Wide-field retinal mosaic image — 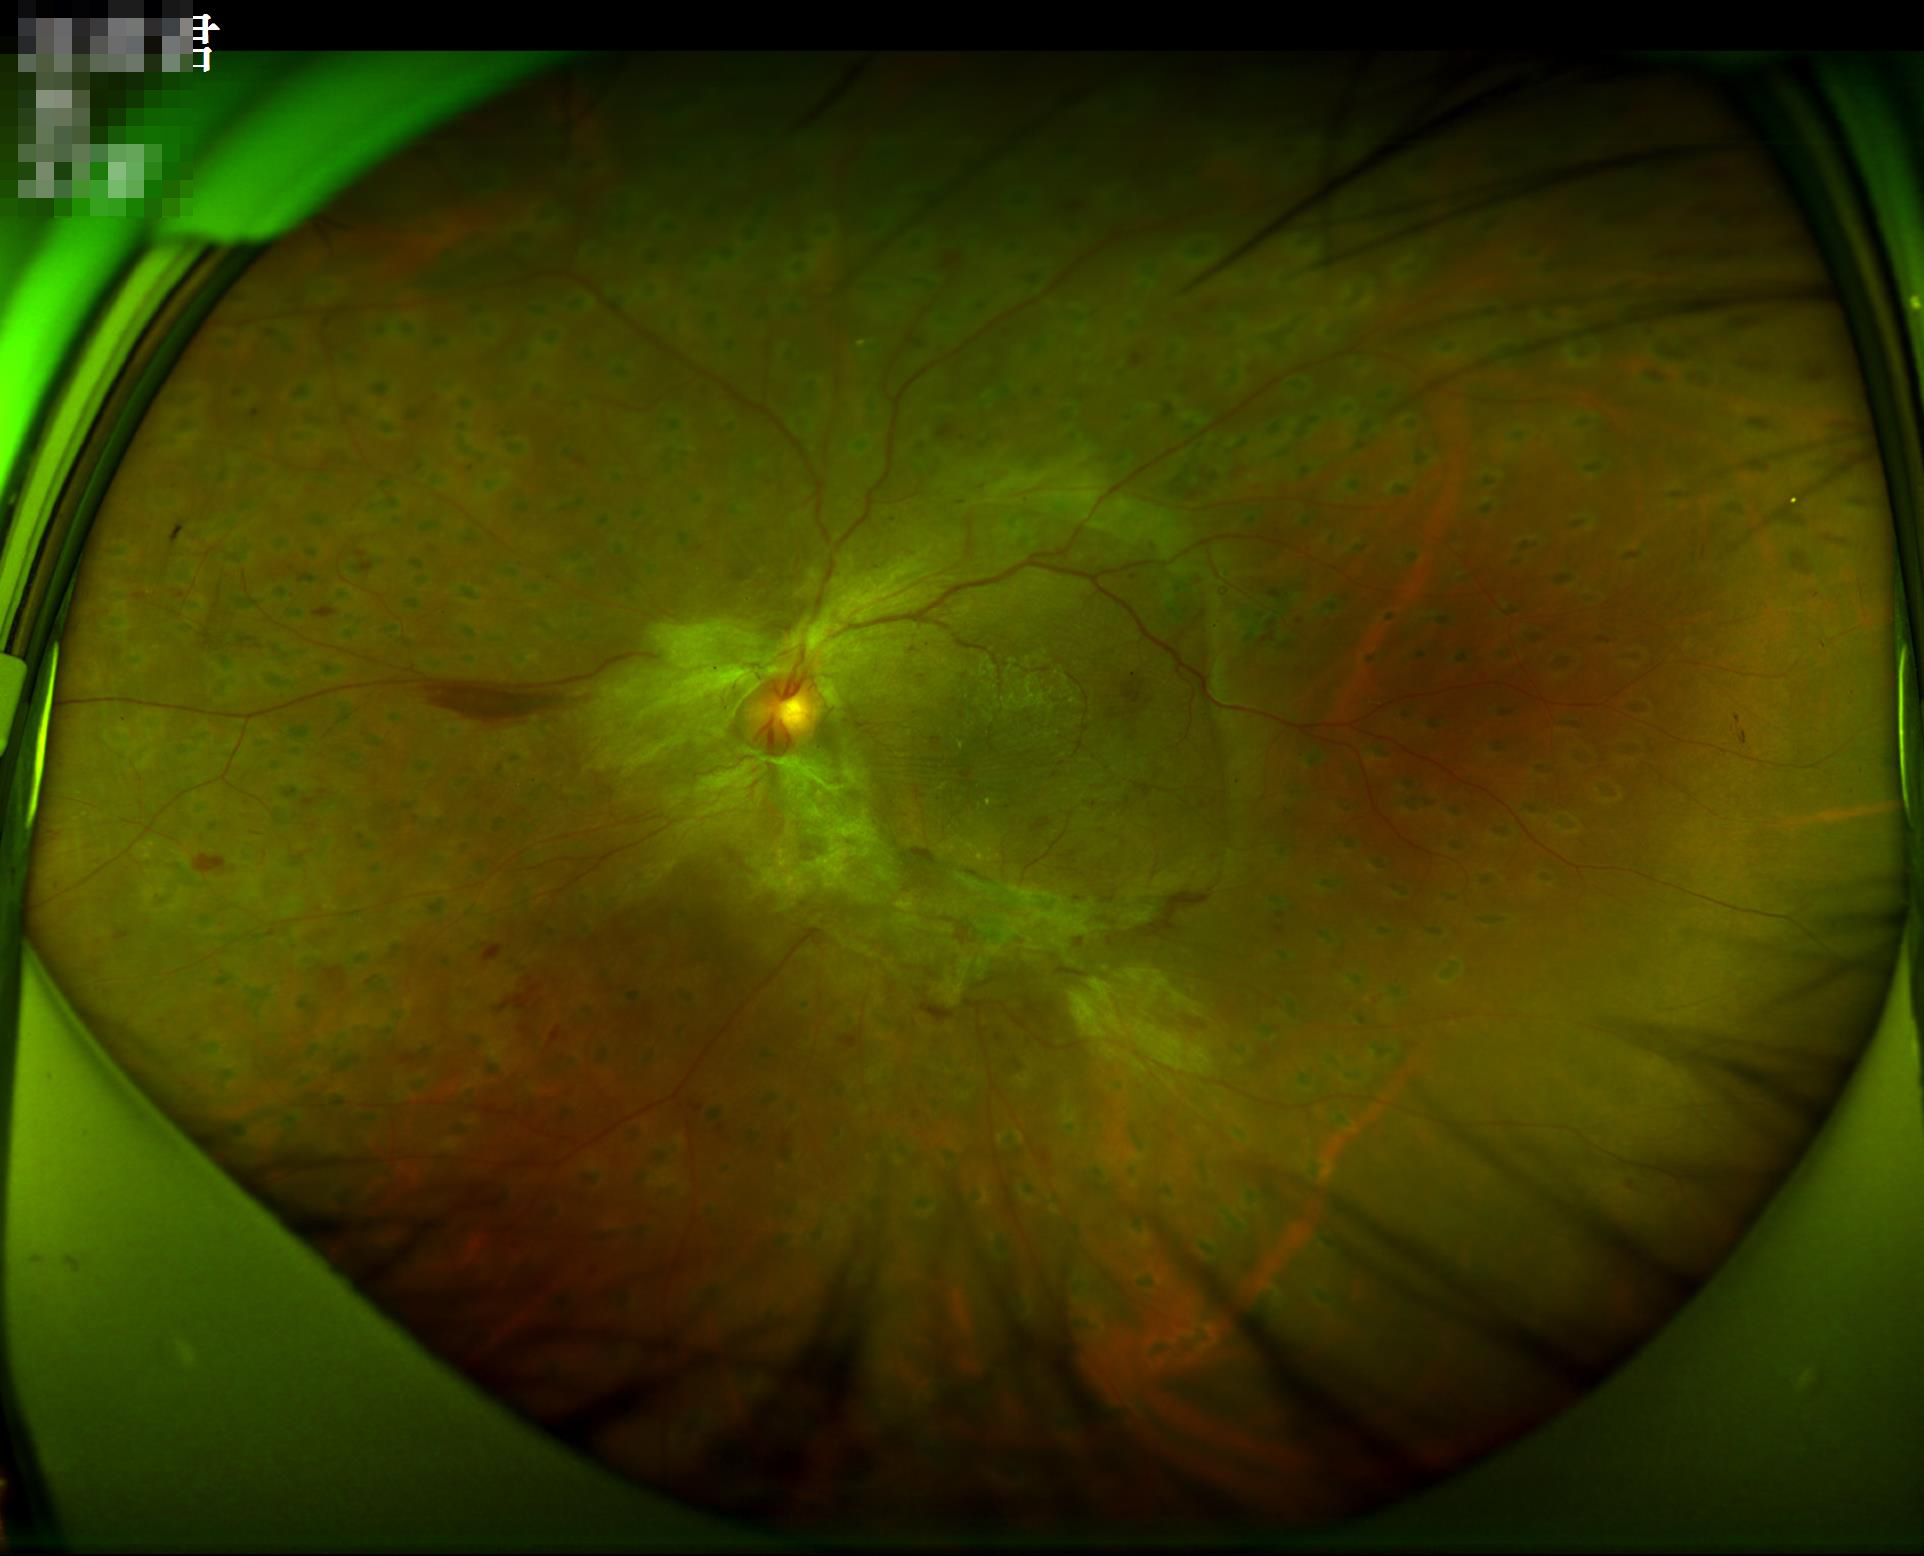

Contrast is good.
The image is clear.
Illumination and color balance are good.